Wide-field contact fundus photograph of an infant · 1240x1240px
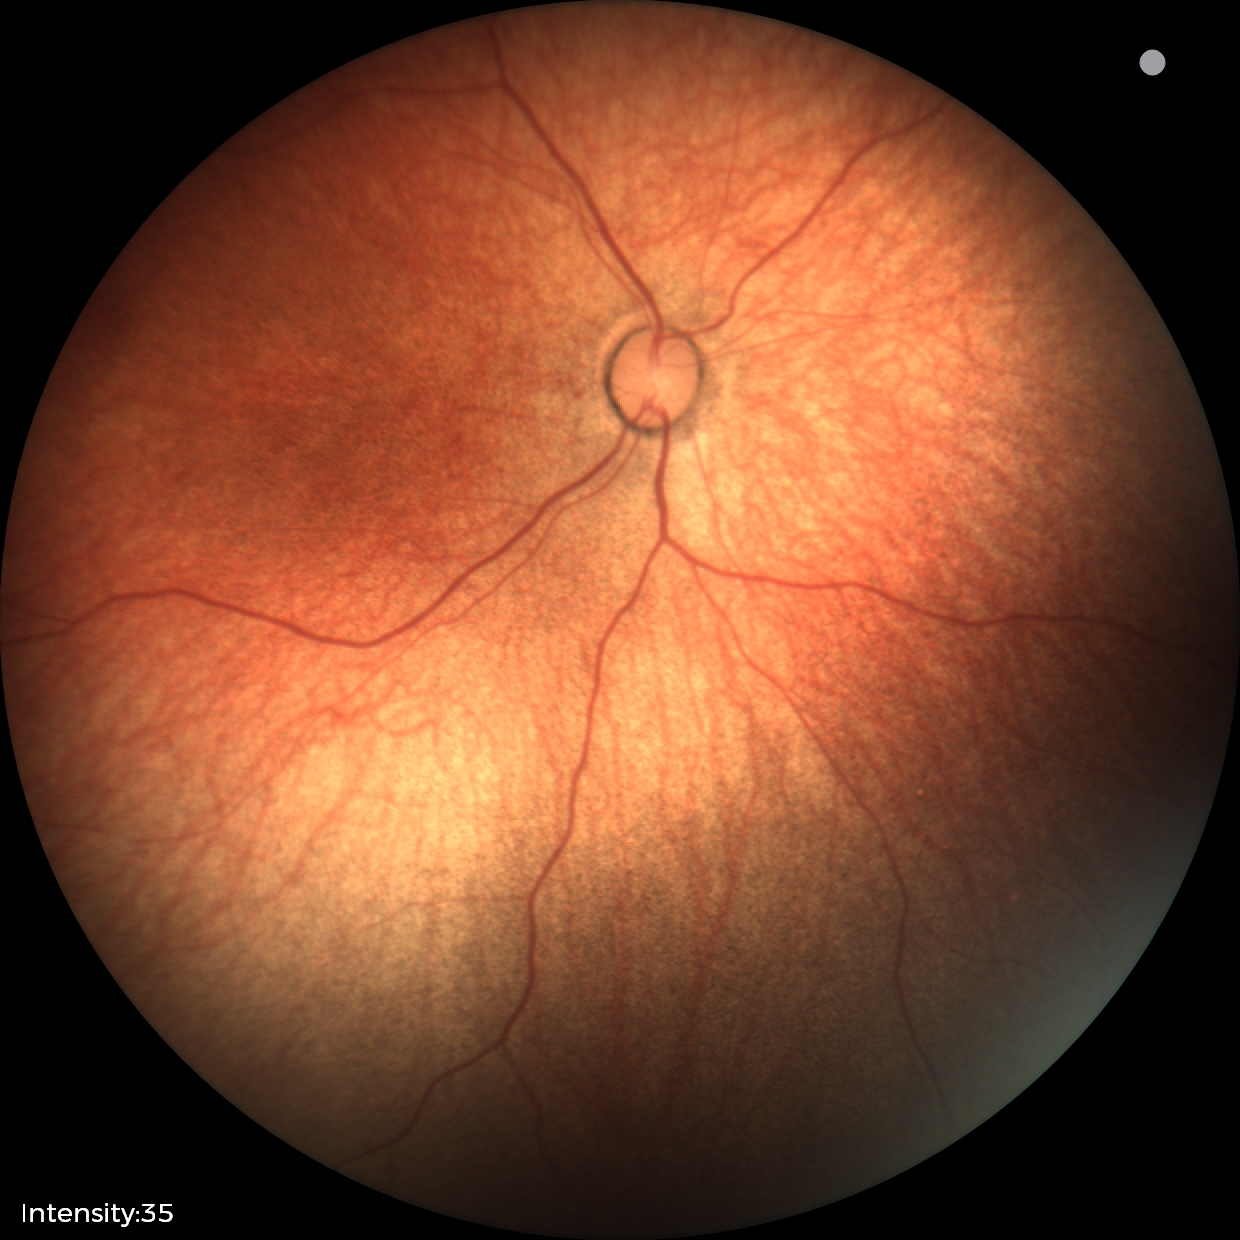
Screening diagnosis: no pathology identified